Image size 848x848 · camera: NIDEK AFC-230: 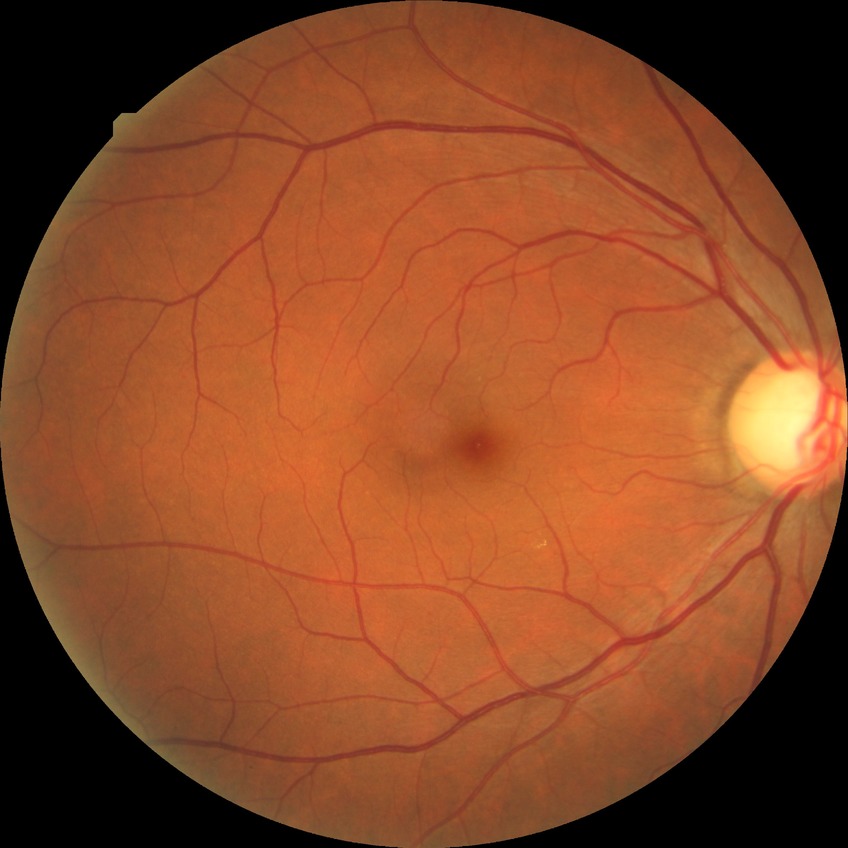
Davis grade: NDR.